Retinal fundus photograph. FOV: 45 degrees. 2352 by 1568 pixels
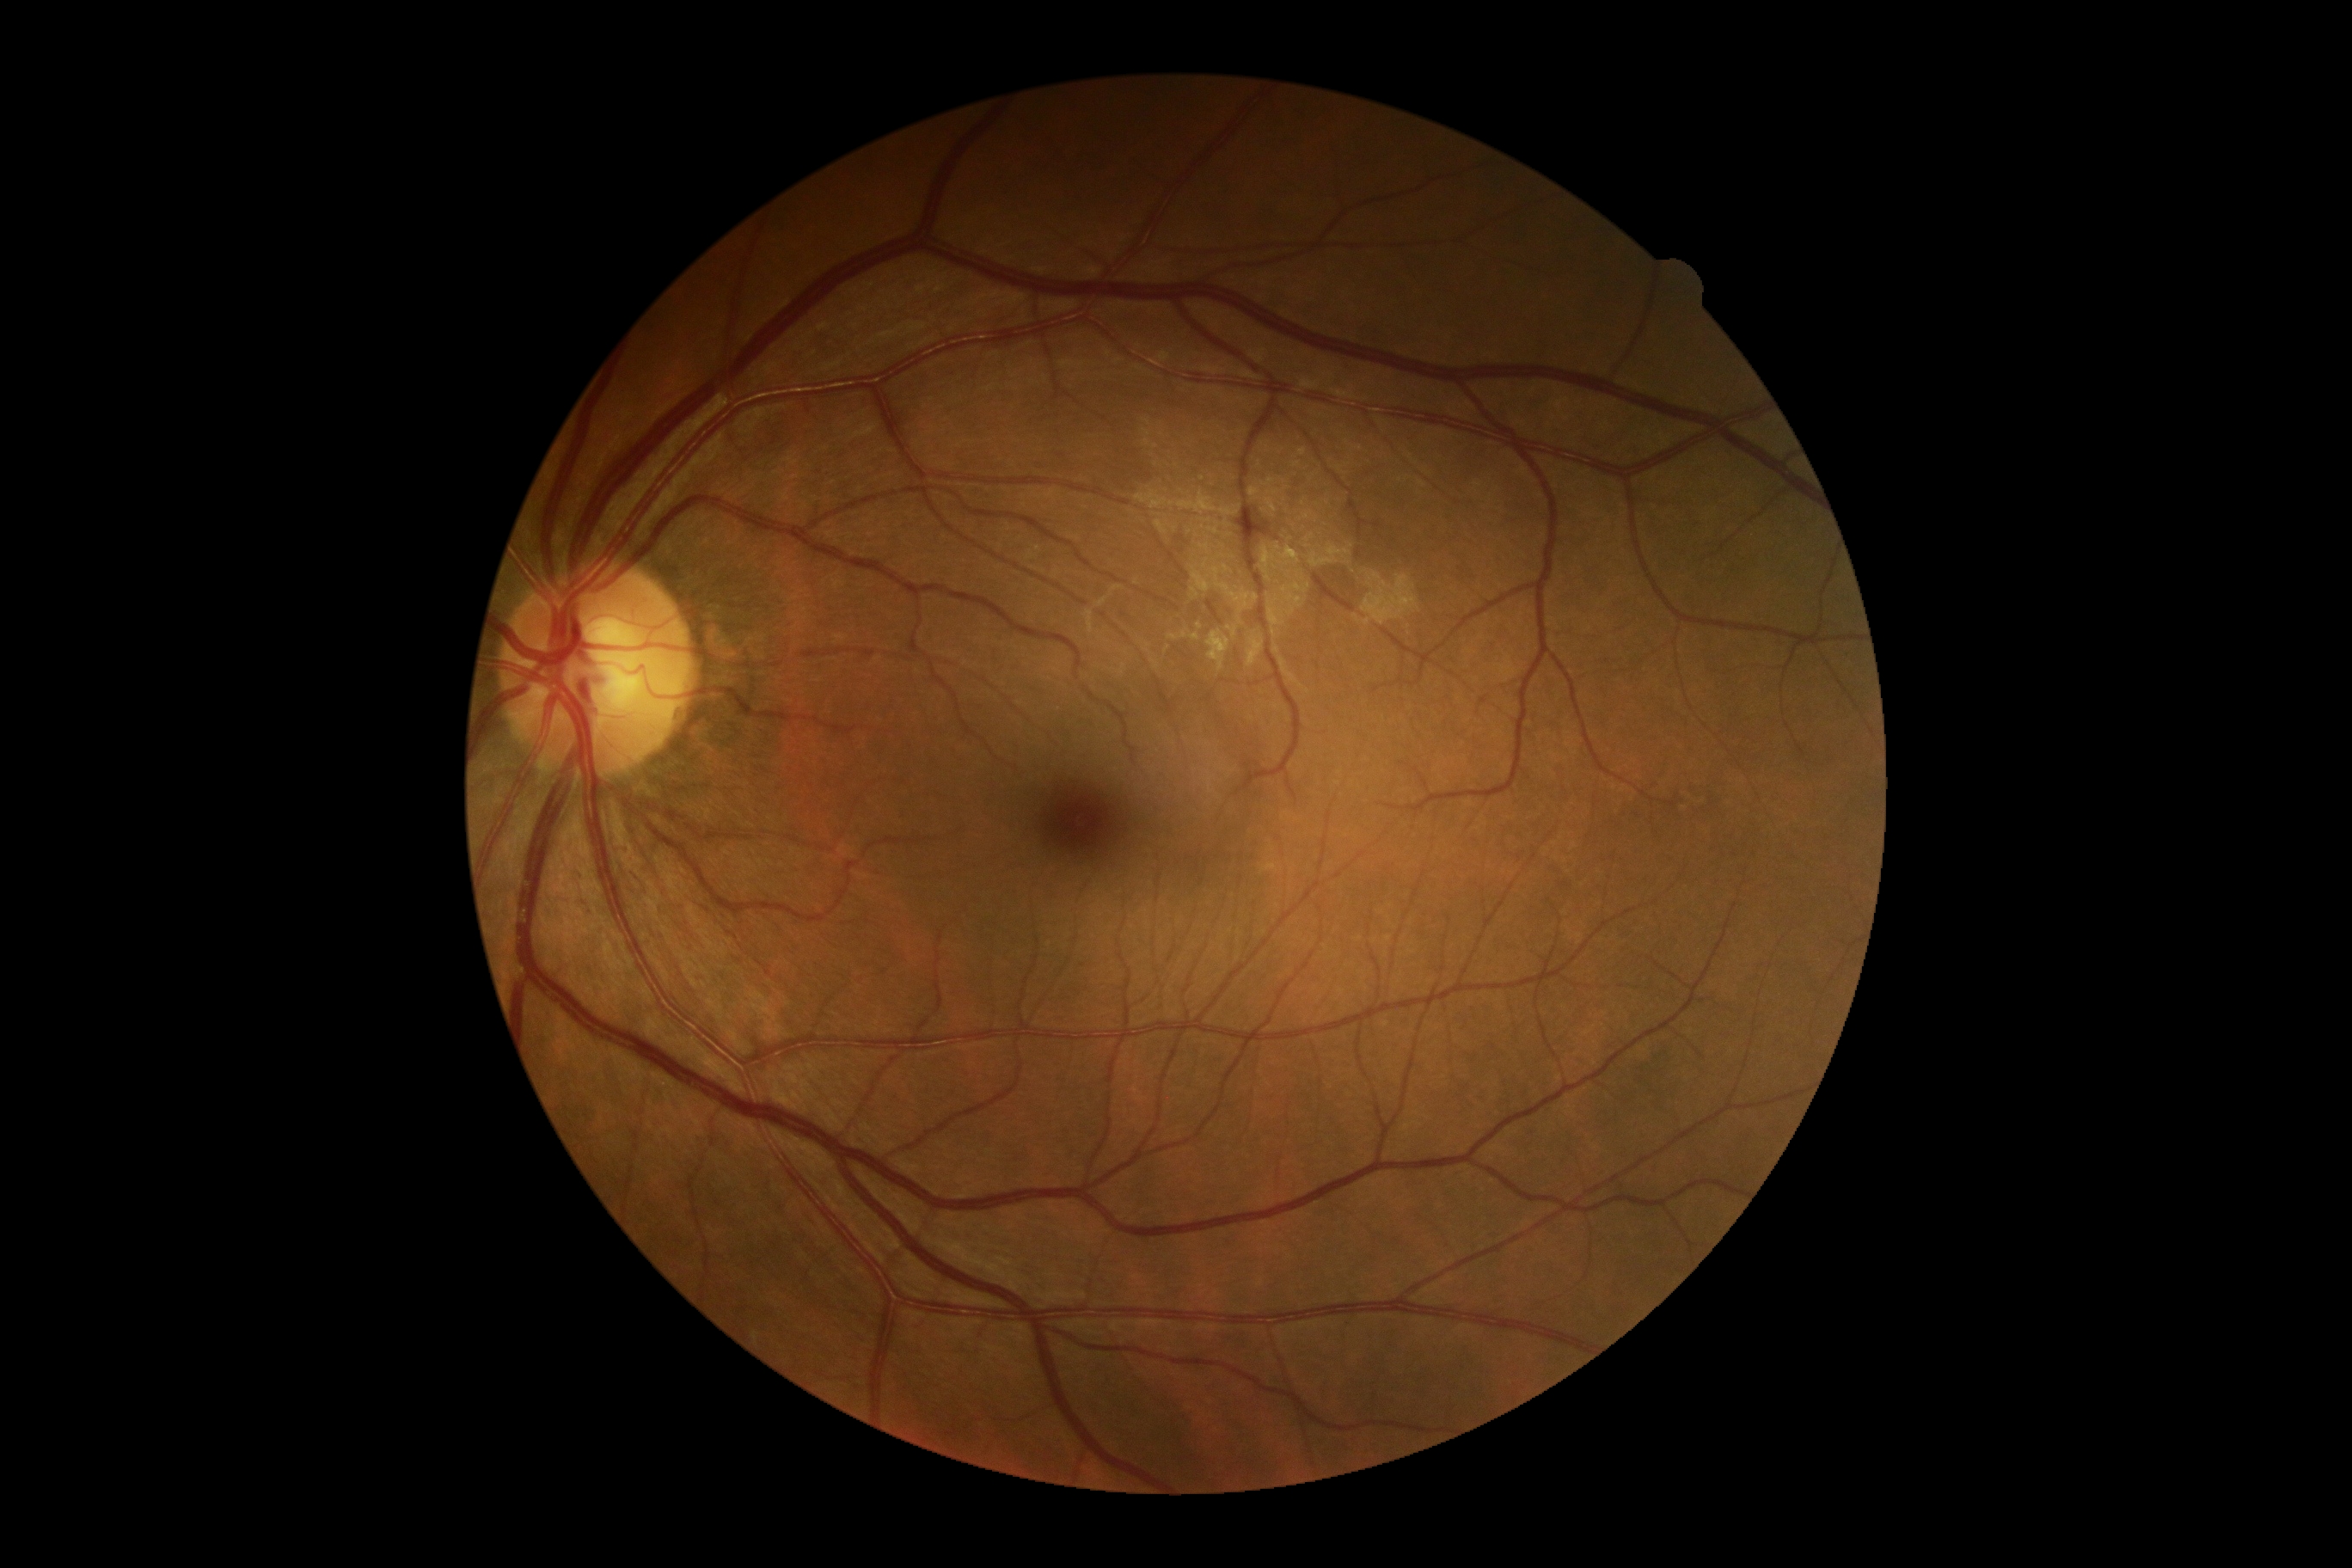 DR is no apparent retinopathy (grade 0).